757x715px
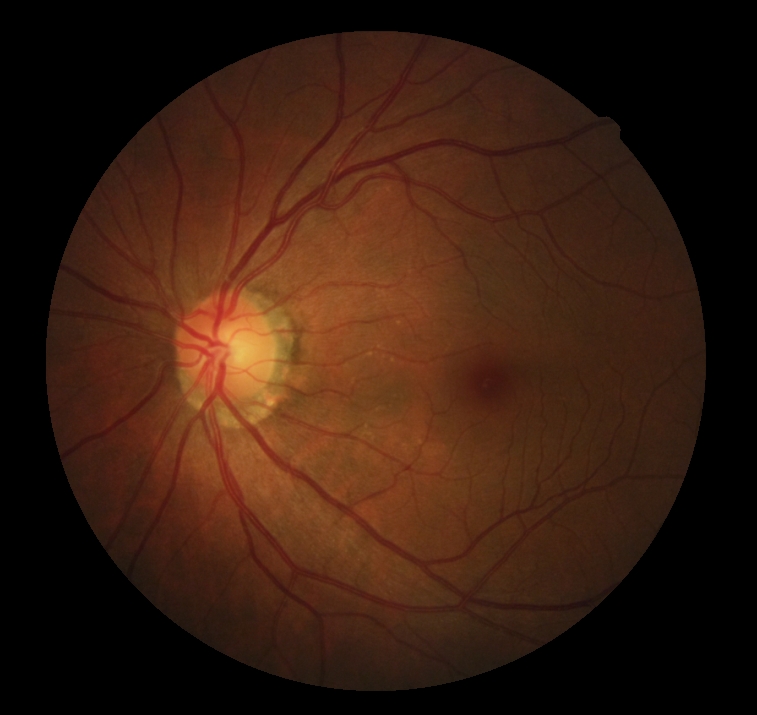
DR impression = no apparent DR; retinopathy grade = 0 (no apparent retinopathy).